45° FOV — 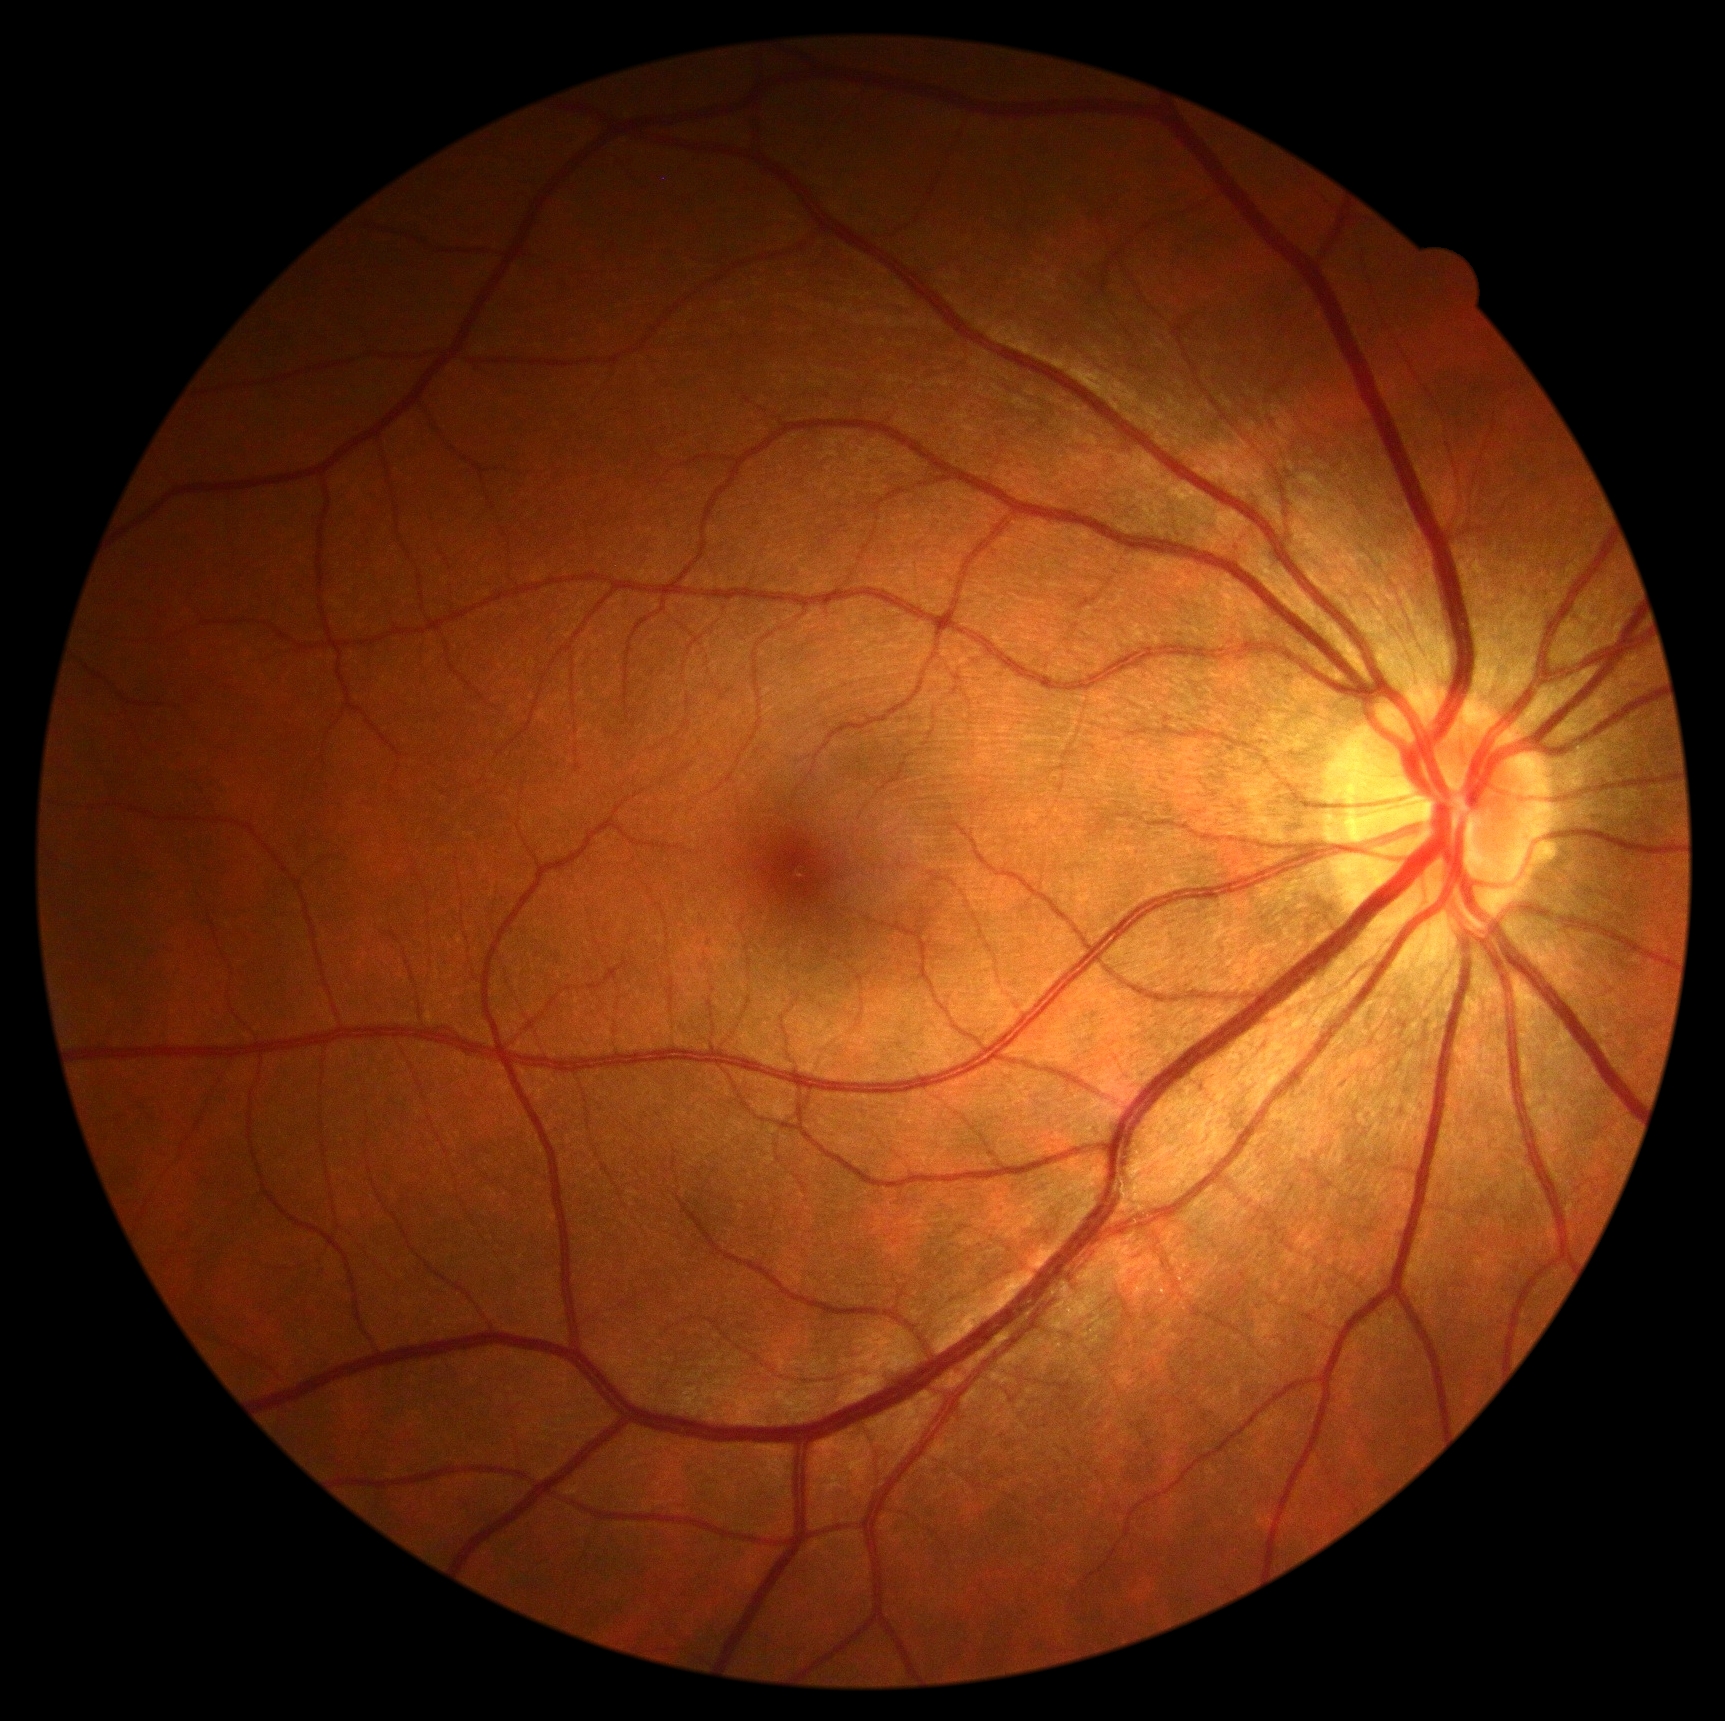 Diabetic retinopathy: 0.